Non-mydriatic fundus camera · cropped to the optic nerve head · 240 by 240 pixels:
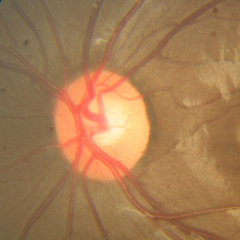 The image shows no glaucomatous optic neuropathy.